Retinal fundus photograph. 45-degree field of view.
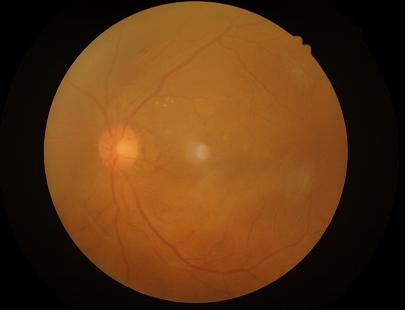
Vessels and details are readily distinguishable. Out of focus; structures are indistinct. No over- or under-exposure. Overall quality is poor; the image is difficult to grade.